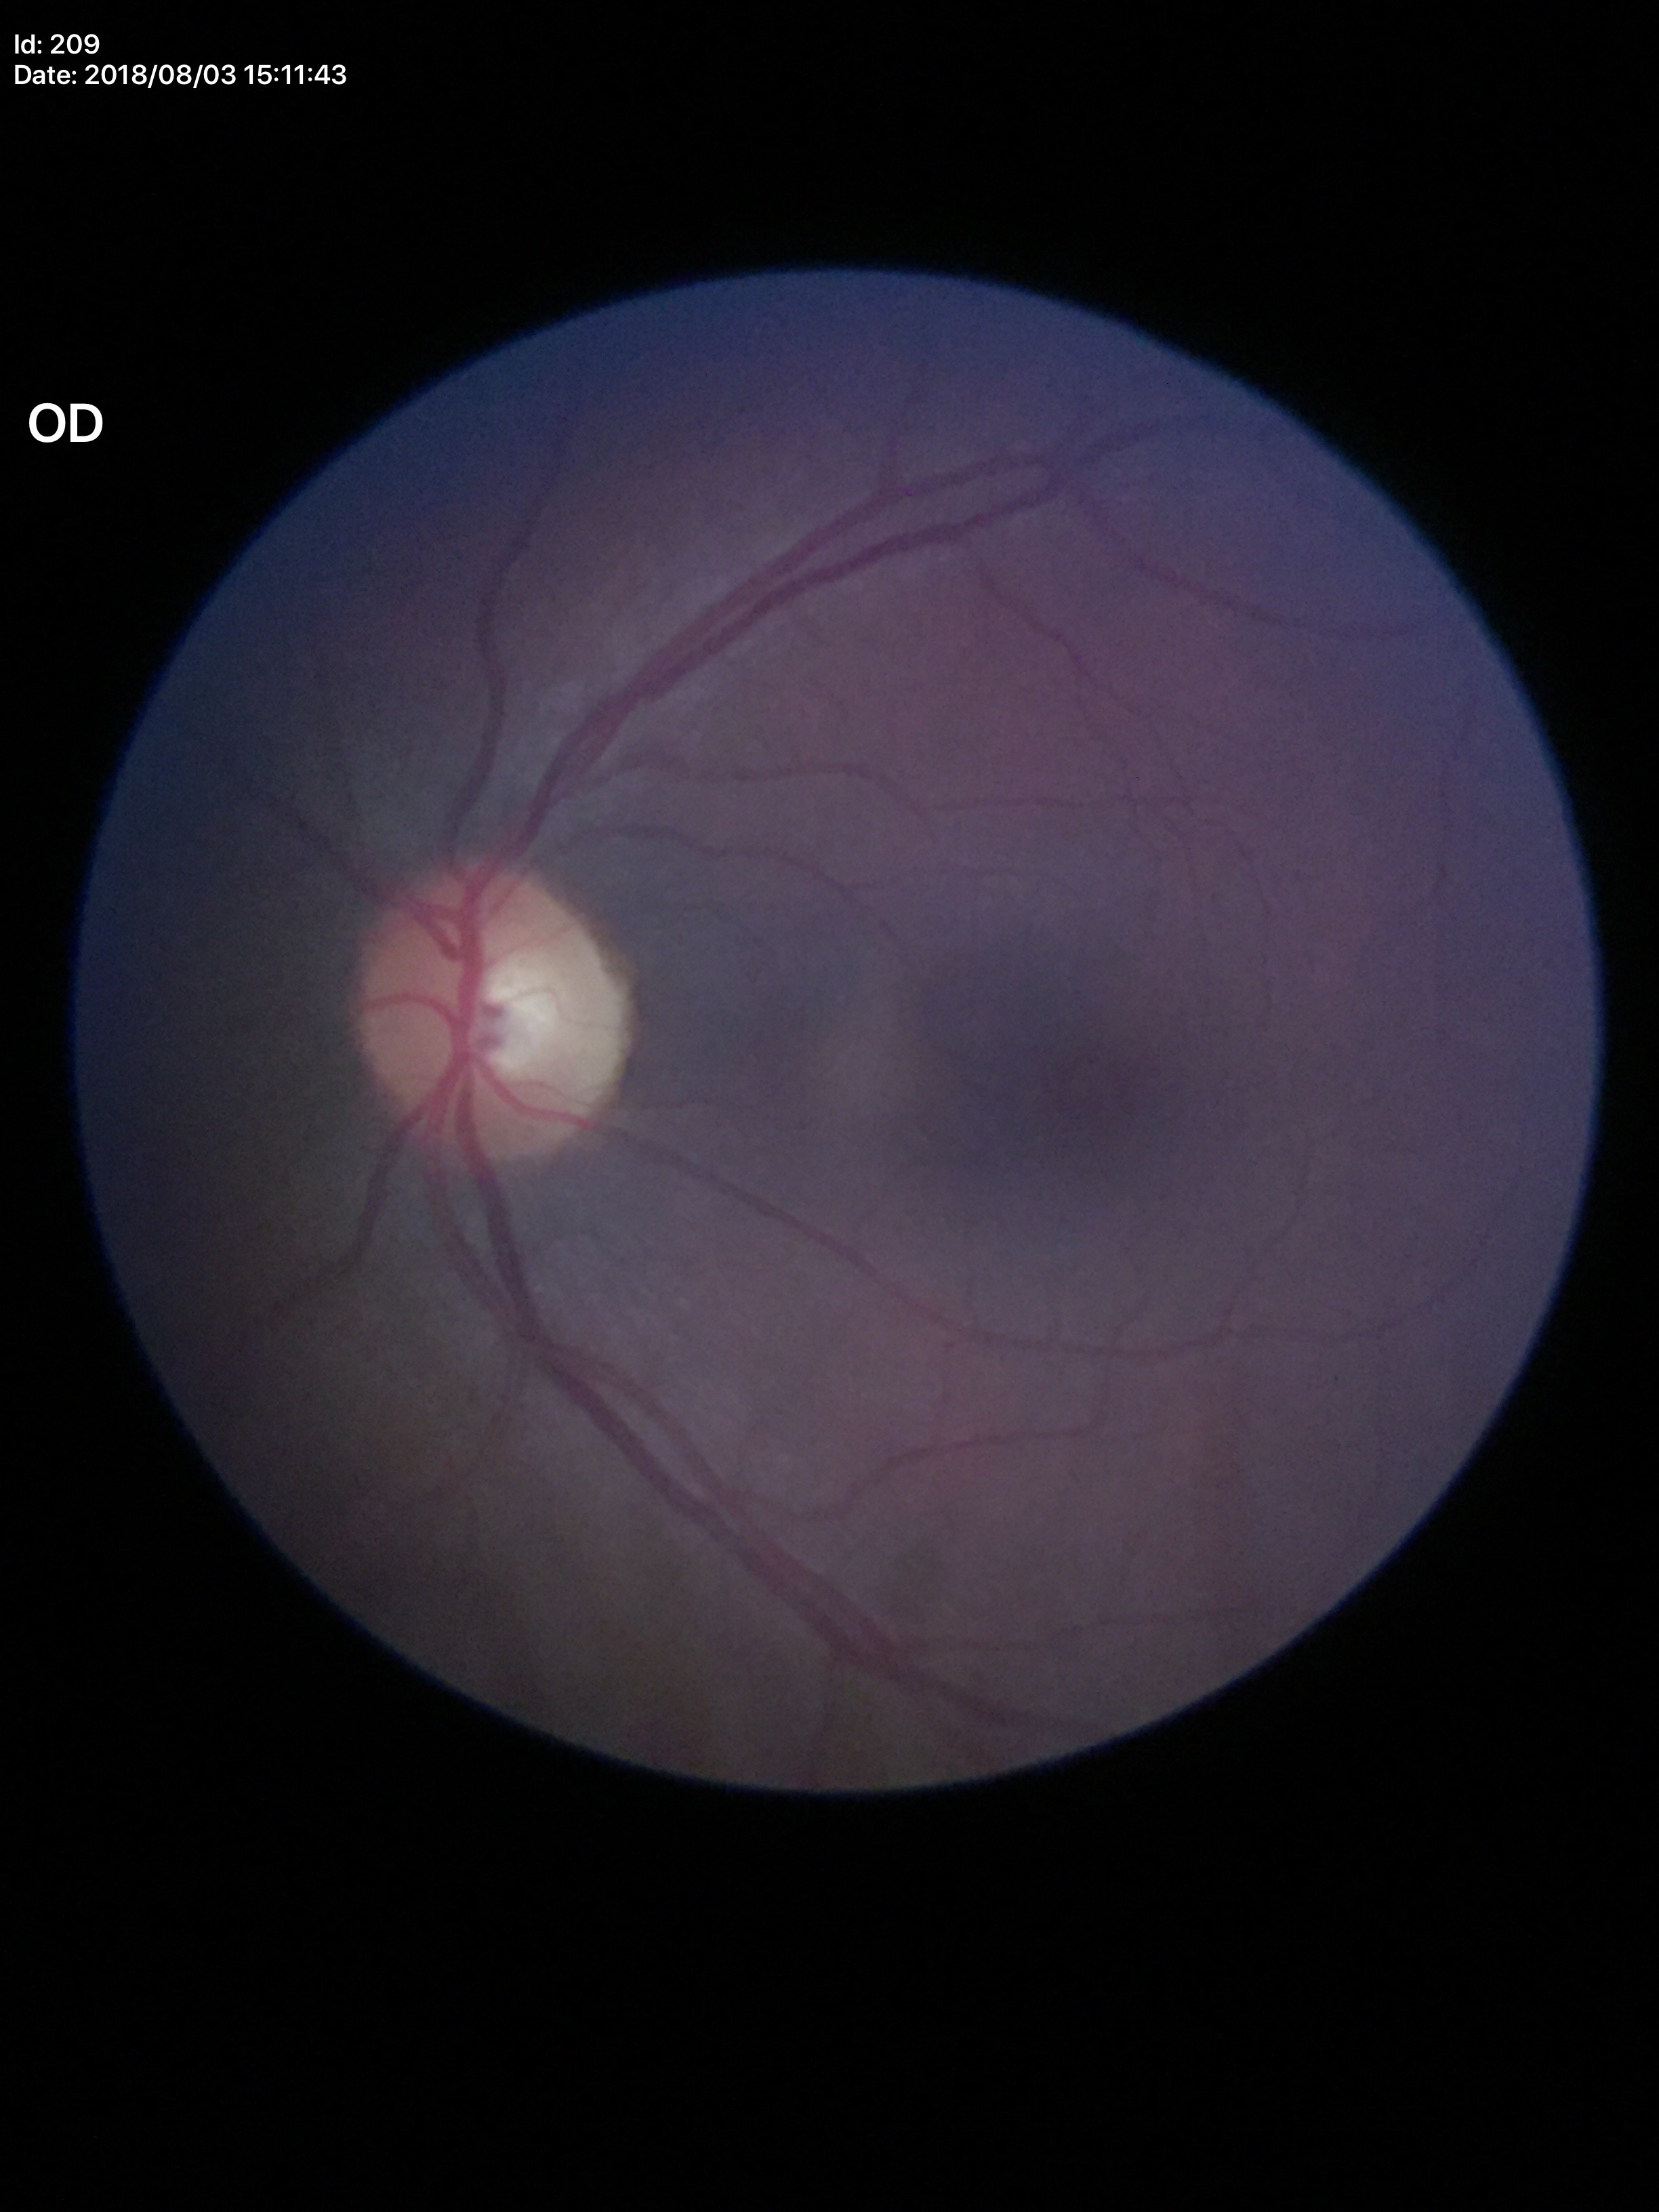 Glaucoma decision: negative. Vertical C/D ratio (VCDR): 0.56. Horizontal C/D ratio (HCDR) is 0.48.